Wide-field fundus photograph of an infant; 1440 x 1080 pixels.
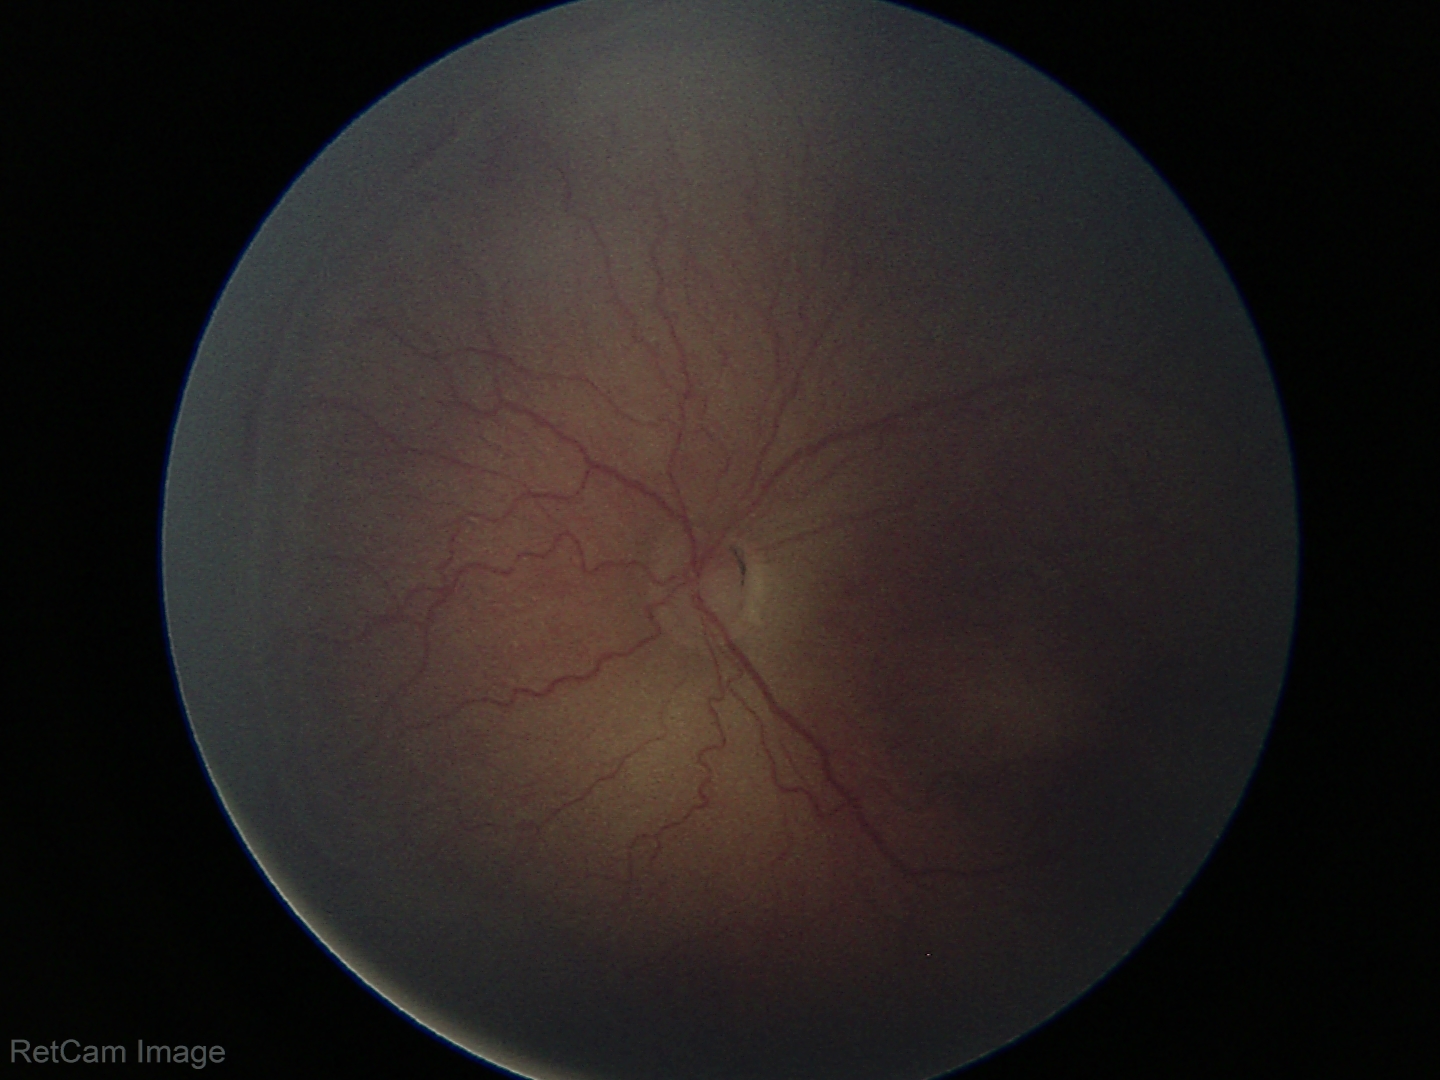
Diagnosis from this screening exam: retinopathy of prematurity stage 2 — ridge with height and width at the demarcation line. Plus disease absent.